Macula at the center of the field. 50° field of view — 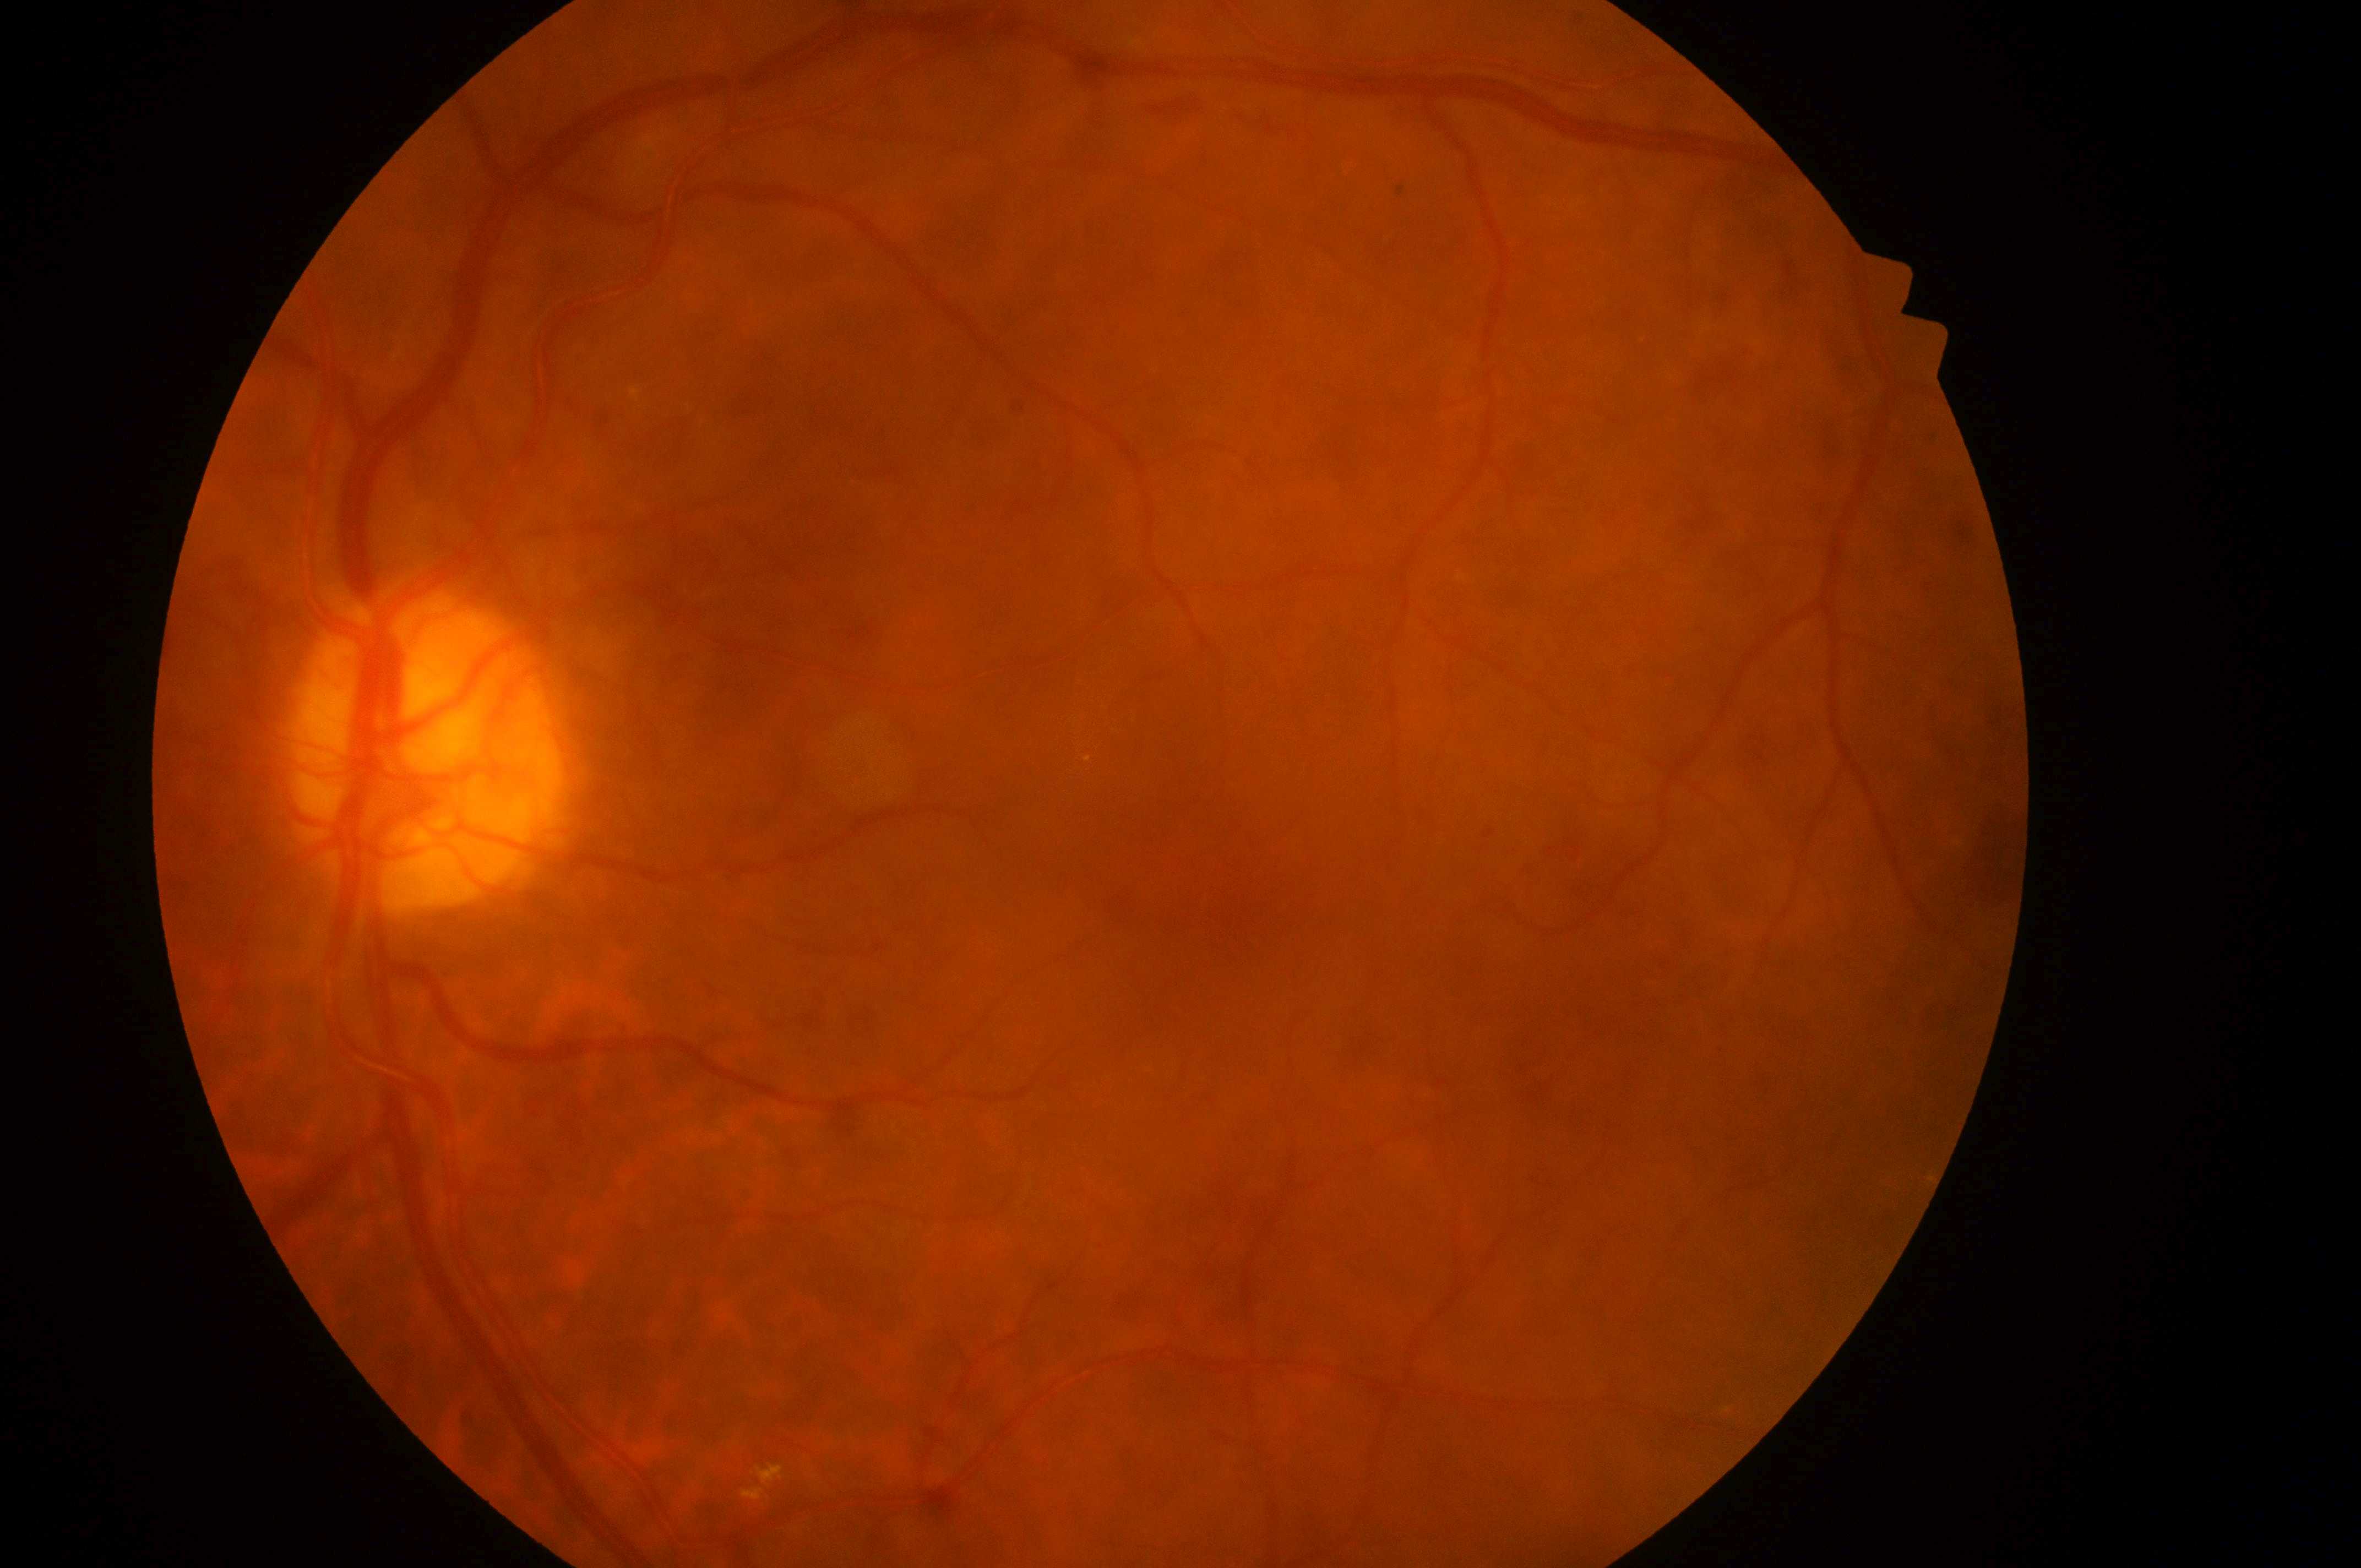 Q: Fovea center?
A: (1200, 868)
Q: What is the laterality?
A: oculus sinister
Q: Where is the optic disc?
A: (416, 763)
Q: Diabetic retinopathy severity?
A: grade 4 (PDR)
Q: DME grade?
A: high risk (grade 2)